FOV: 45 degrees, NIDEK AFC-230 fundus camera, CFP — 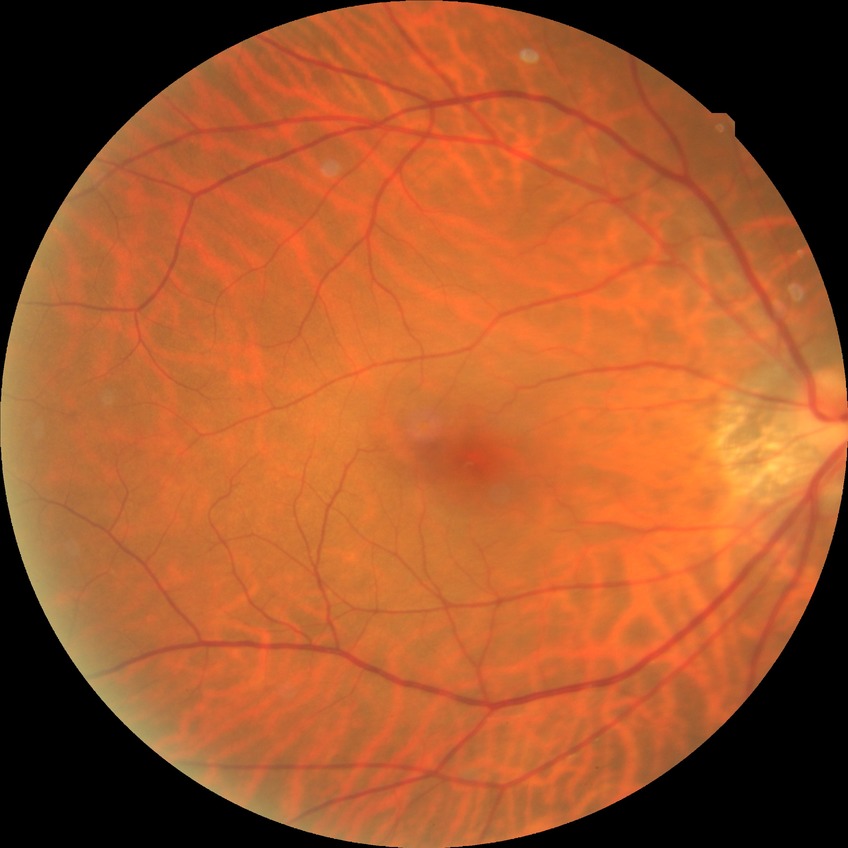

No apparent diabetic retinopathy. Davis DR grade is NDR.